Pediatric retinal photograph (wide-field). Clarity RetCam 3, 130° FOV: 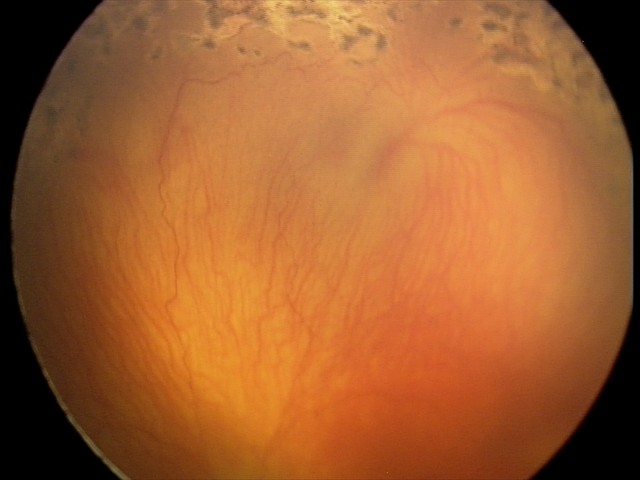 Diagnosis from this screening exam: aggressive retinopathy of prematurity. Plus disease present.